Ultra-widefield (UWF) fundus image.
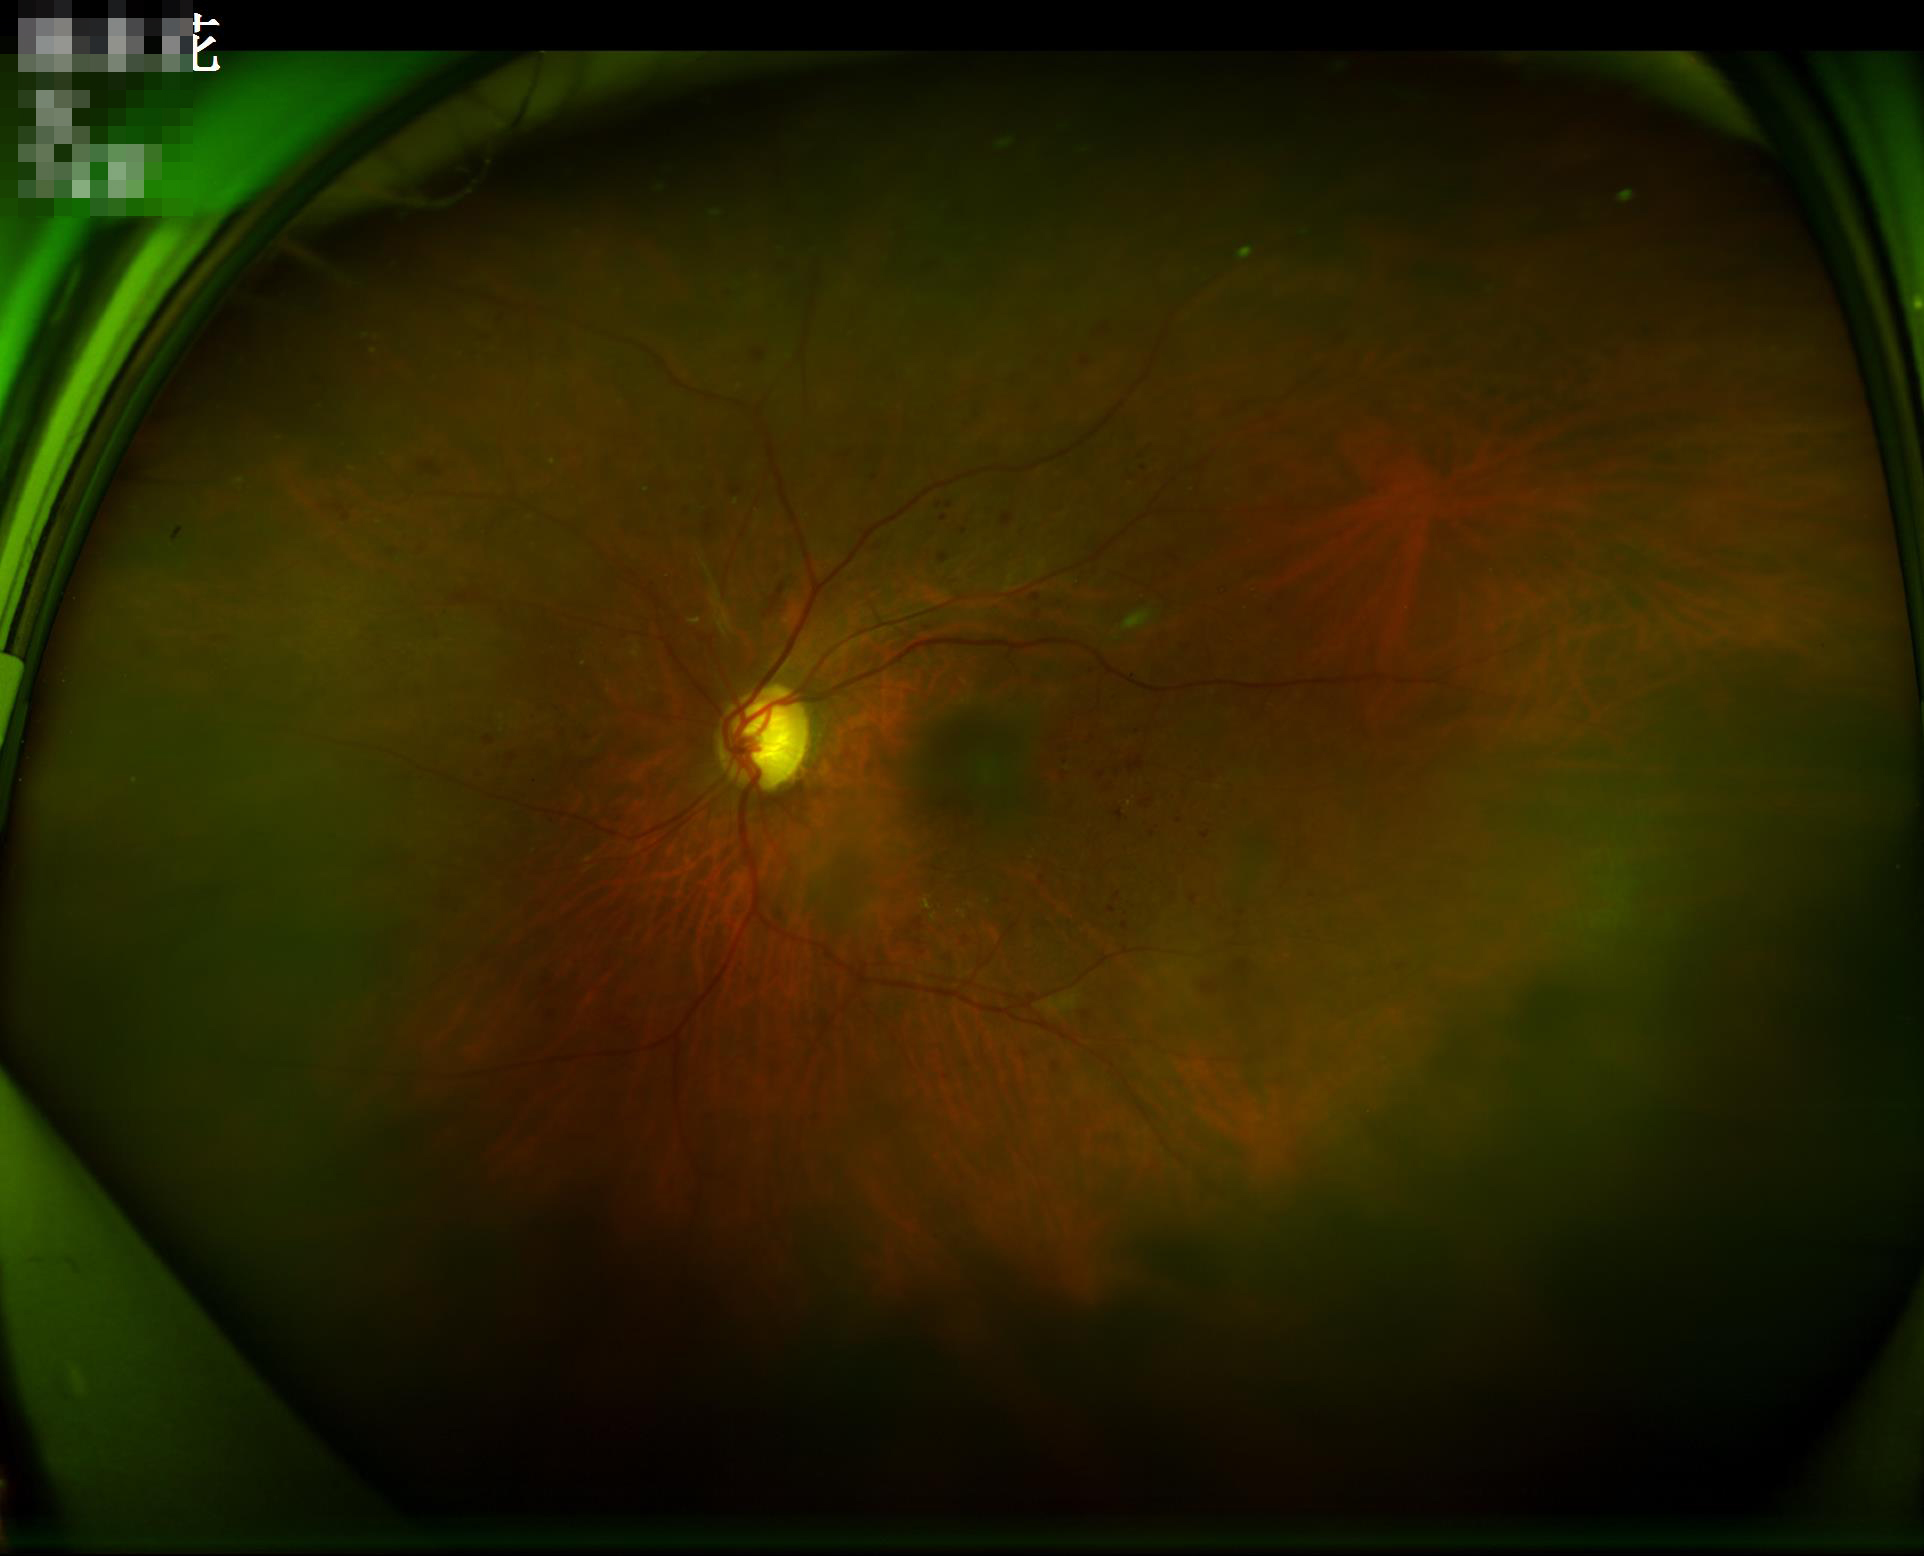 Image quality: illumination/color: suboptimal; overall: low.